130° field of view (Clarity RetCam 3) · 640 by 480 pixels · wide-field fundus photograph of an infant: 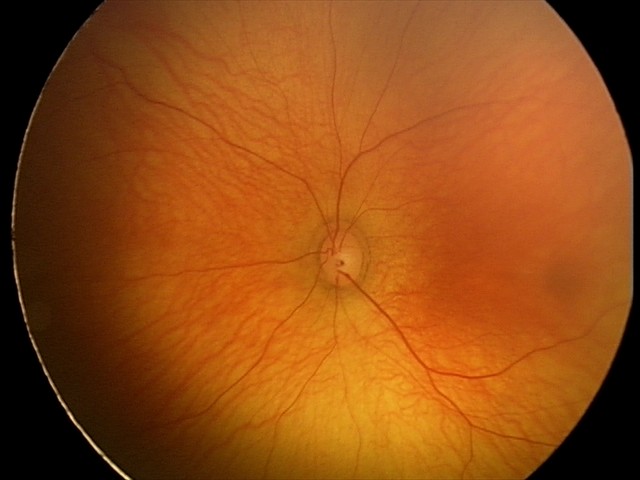 Diagnosis = physiological appearance.